240x240px, captured without pupil dilation
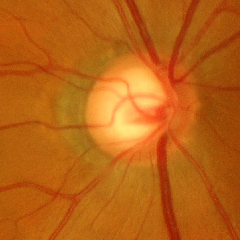 Q: What stage of glaucoma is present?
A: Yes — advanced-stage glaucoma. (Criteria: near-total cupping of the optic nerve head, with or without severe visual field loss within the central 10 degrees of fixation.)